Image size 640x480 · wide-field fundus image from infant ROP screening.
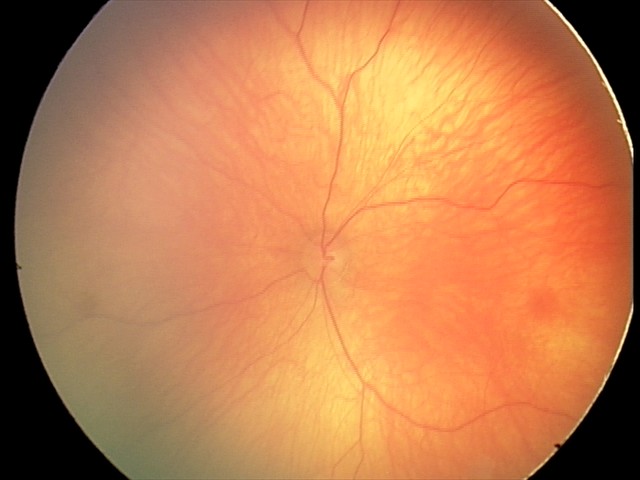

Examination with physiological retinal findings.